2212x1659px, 60° FOV:
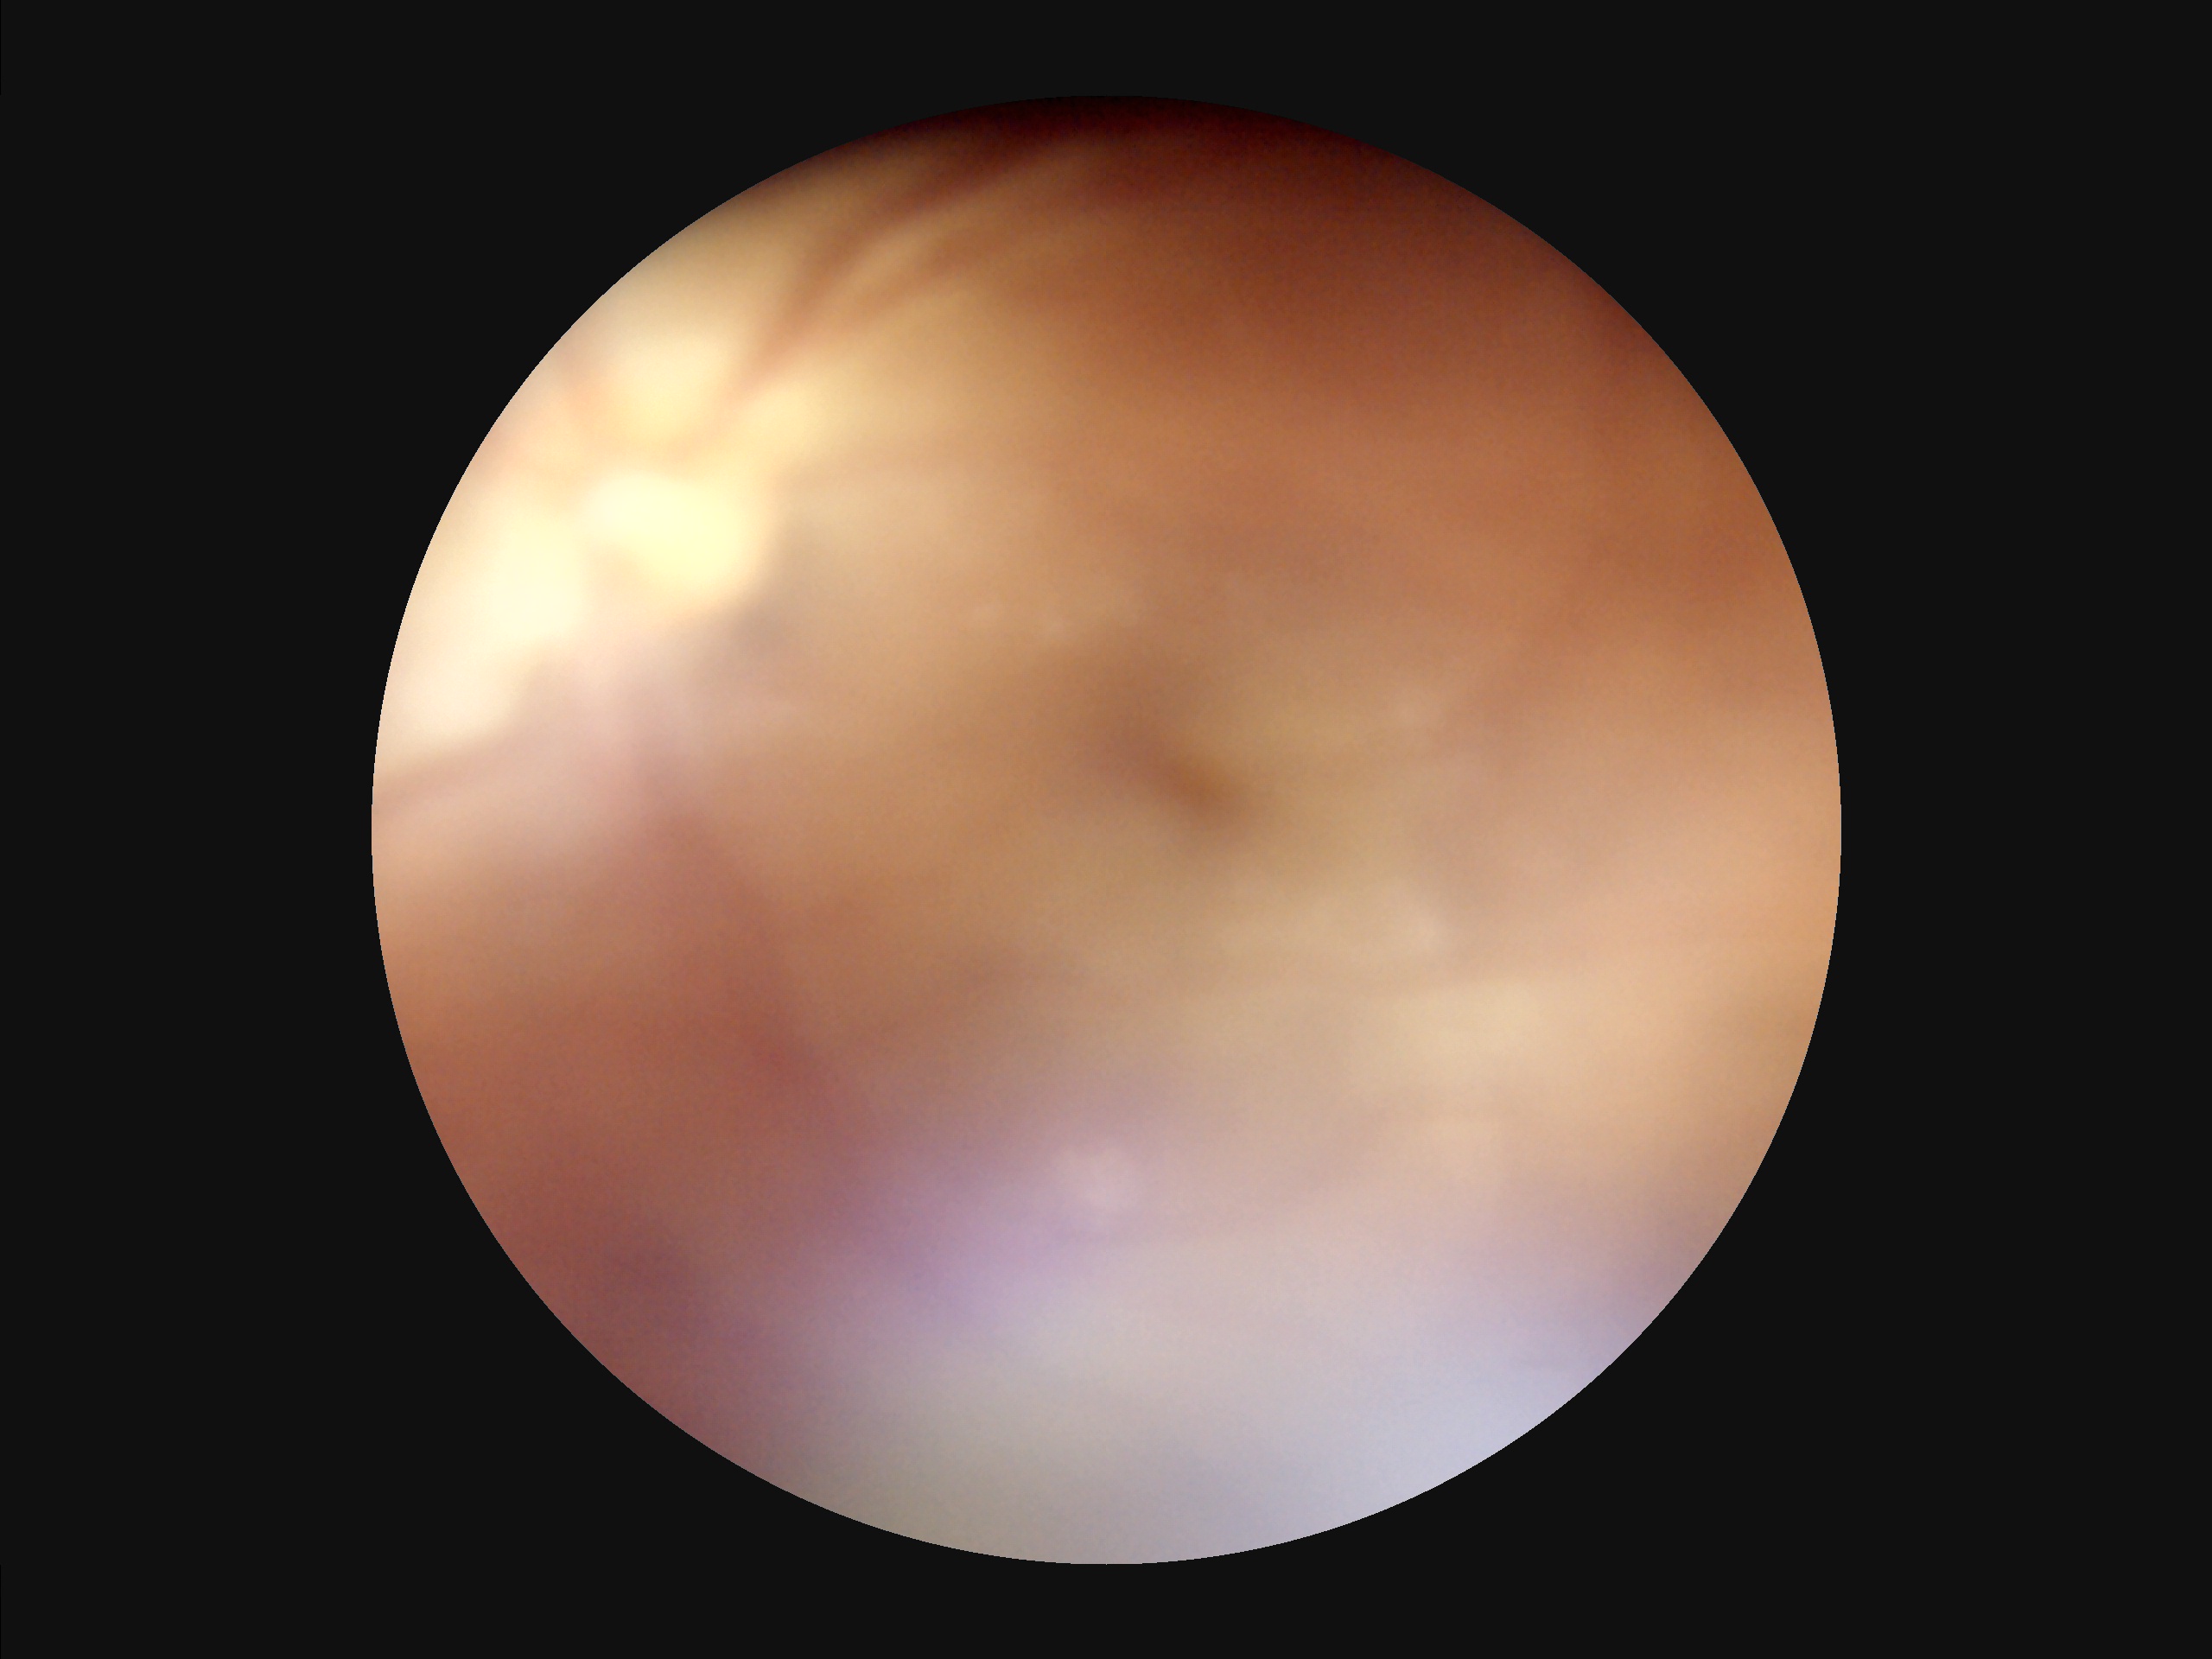
Poor illumination with uneven exposure. Reduced sharpness with visible blur. Image quality is inadequate for diagnostic use. Narrow intensity range; structures are hard to distinguish.